Central posterior field, mydriatic (tropicamide and phenylephrine).
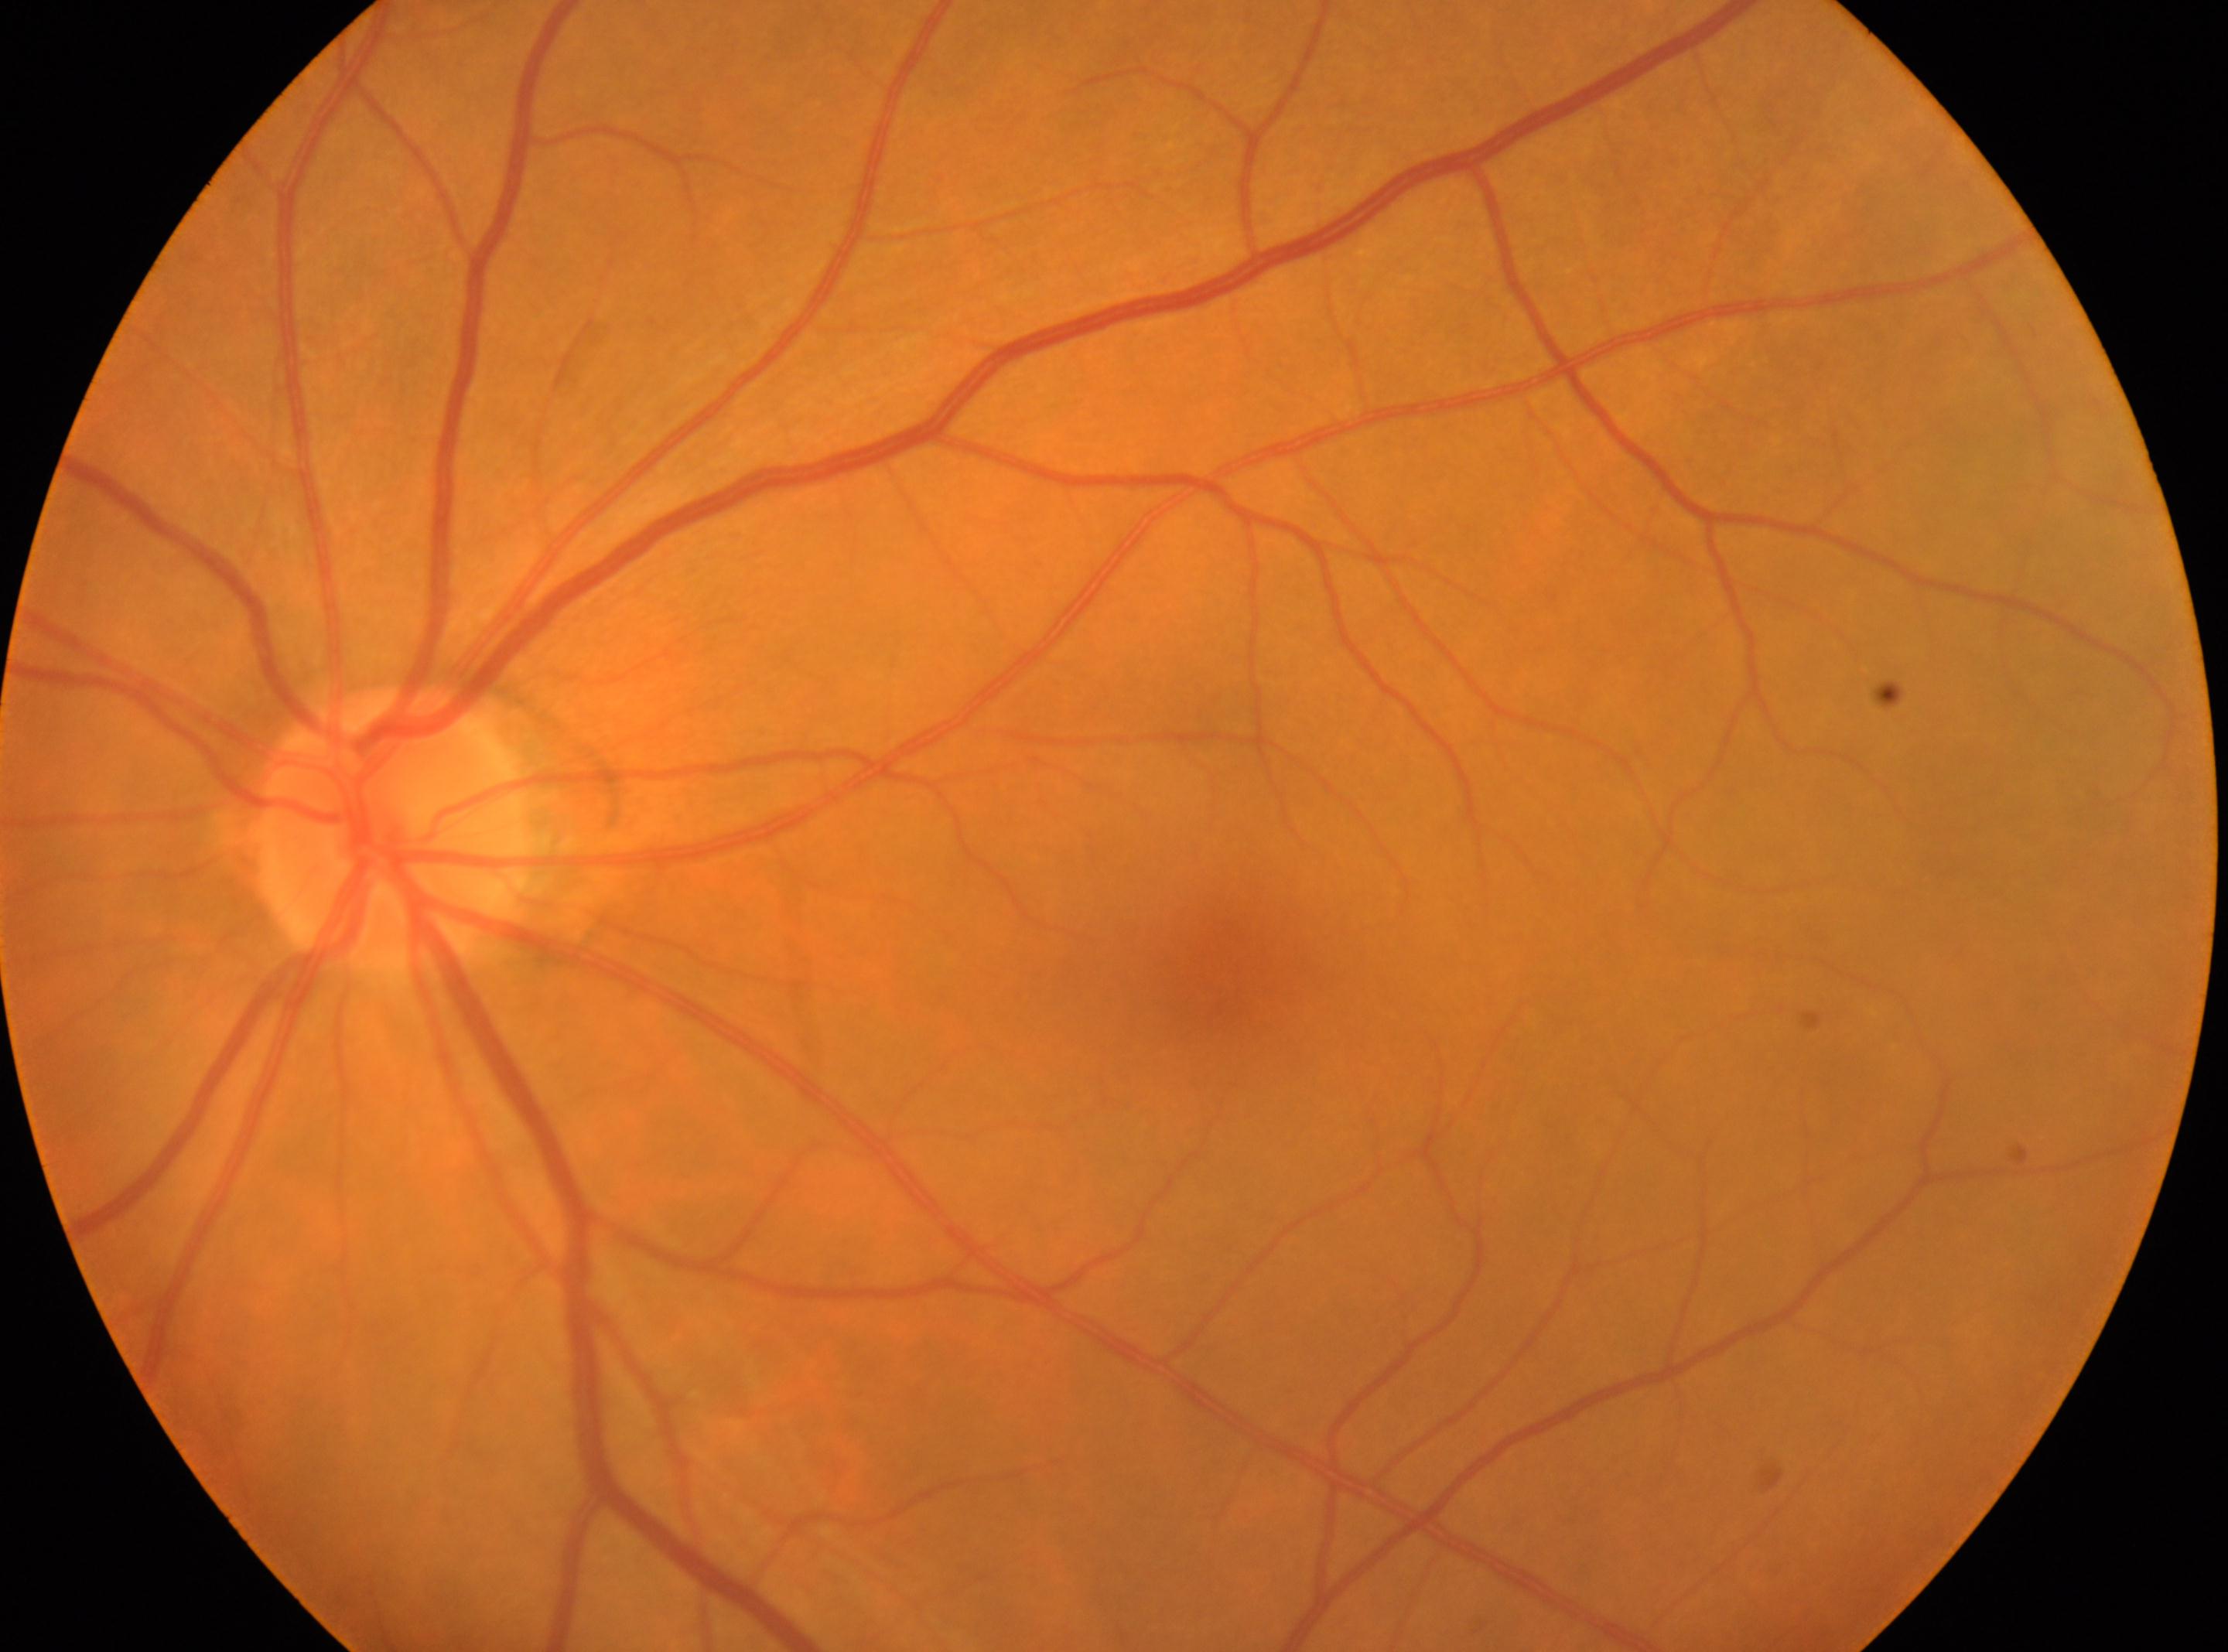

The macula center is at 1227, 985. Optic disc center located at 394, 830. DR grade is 0. Imaged eye: oculus sinister. No apparent diabetic retinopathy.